Phoenix ICON wide-field infant fundus image. 1240x1240px — 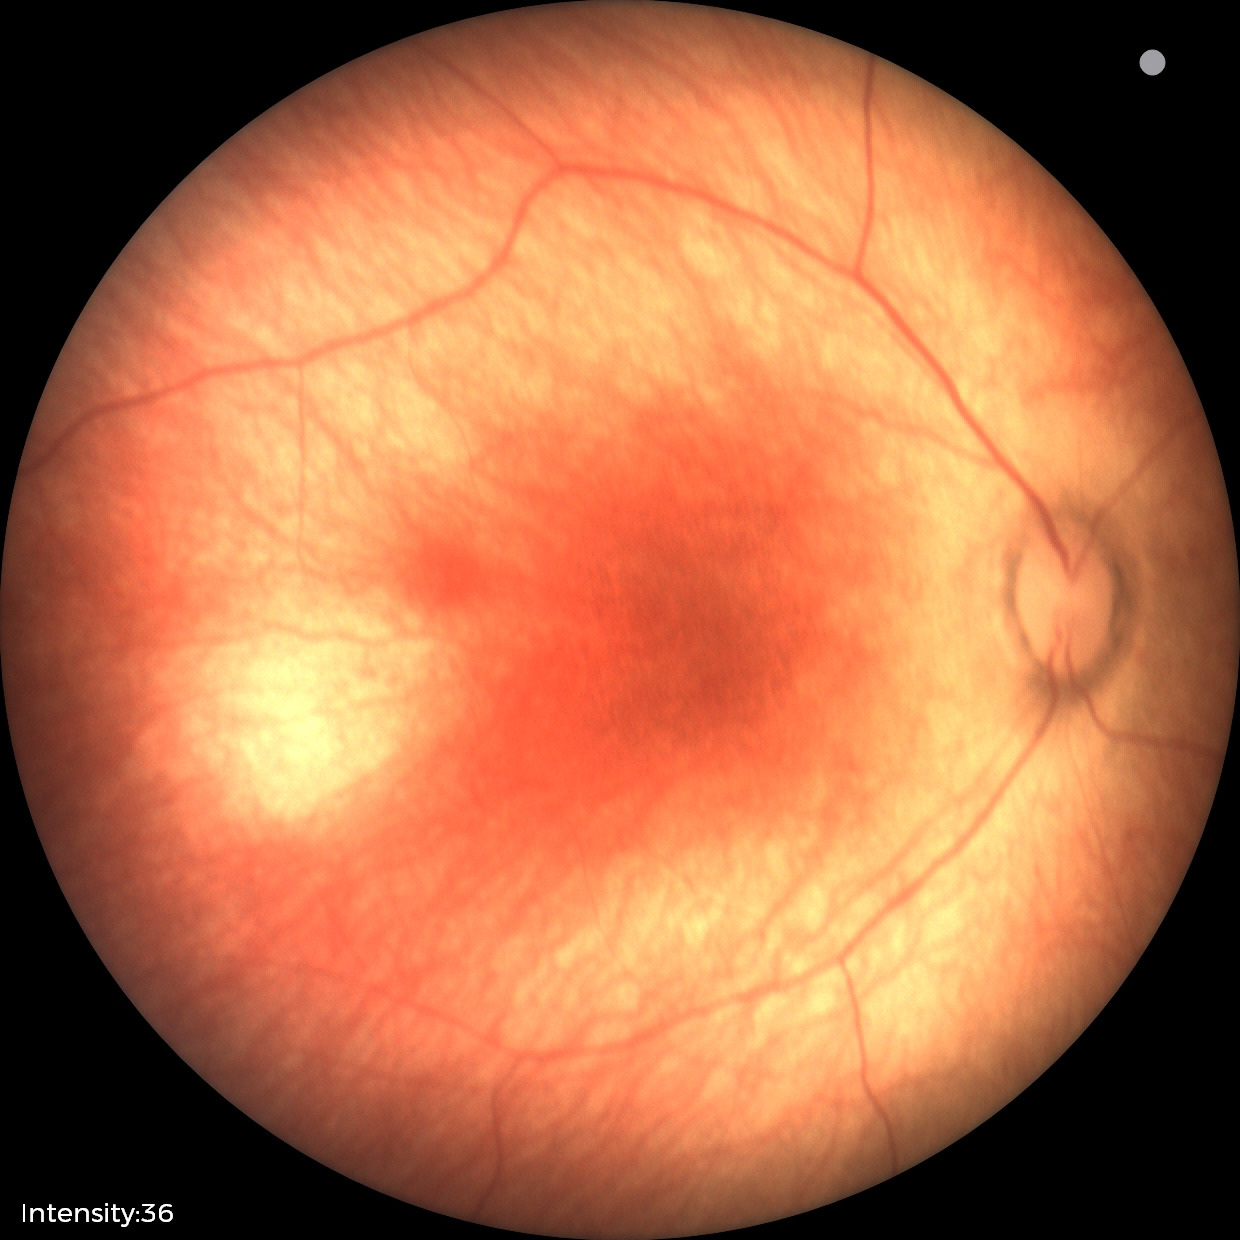 No retinal pathology identified on screening.